45° FOV · modified Davis classification.
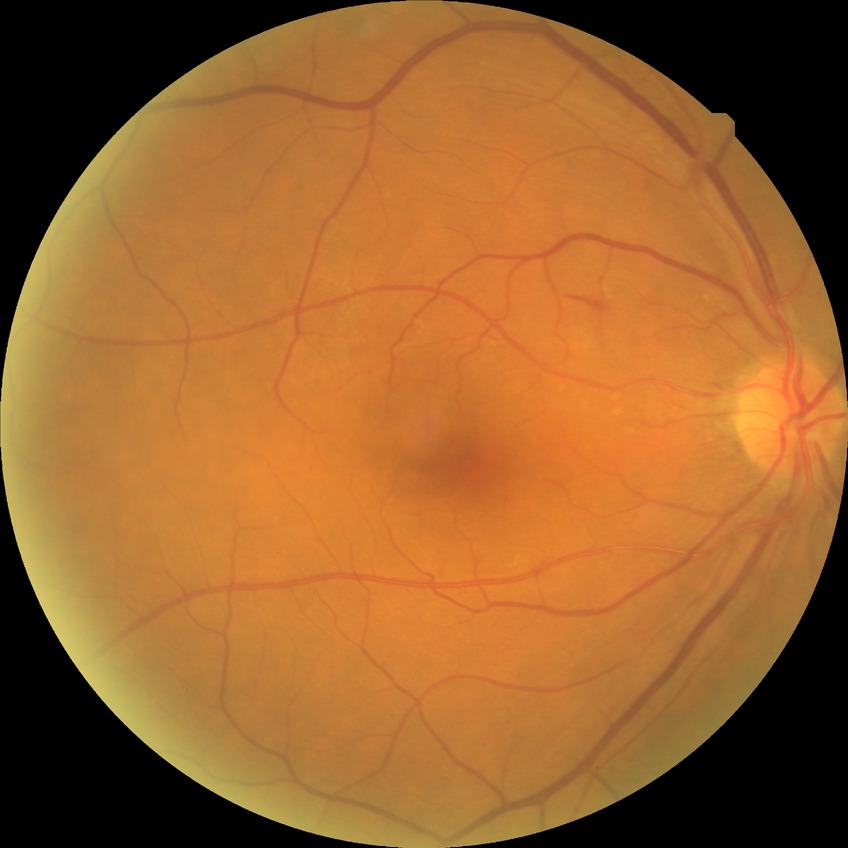 Findings:
* diabetic retinopathy (DR): pre-proliferative diabetic retinopathy (PPDR)